No pharmacologic dilation. Diabetic retinopathy graded by the modified Davis classification. NIDEK AFC-230 fundus camera. Retinal fundus photograph. FOV: 45 degrees:
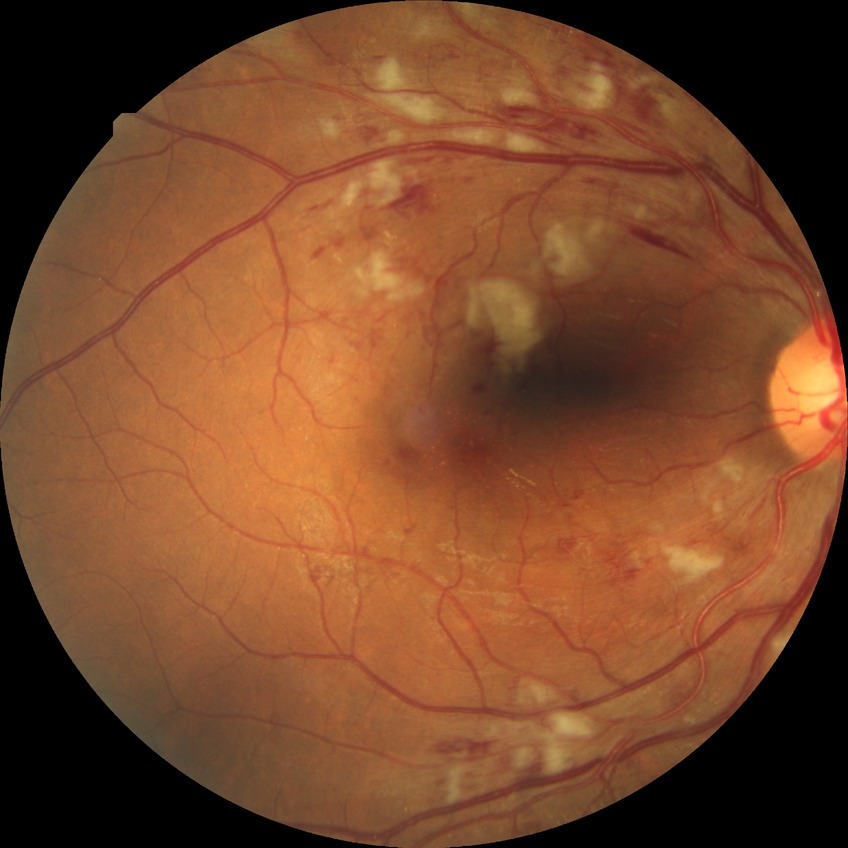

{
  "davis_grade": "PPDR"
}